Modified Davis grading; 45 degree fundus photograph; NIDEK AFC-230: 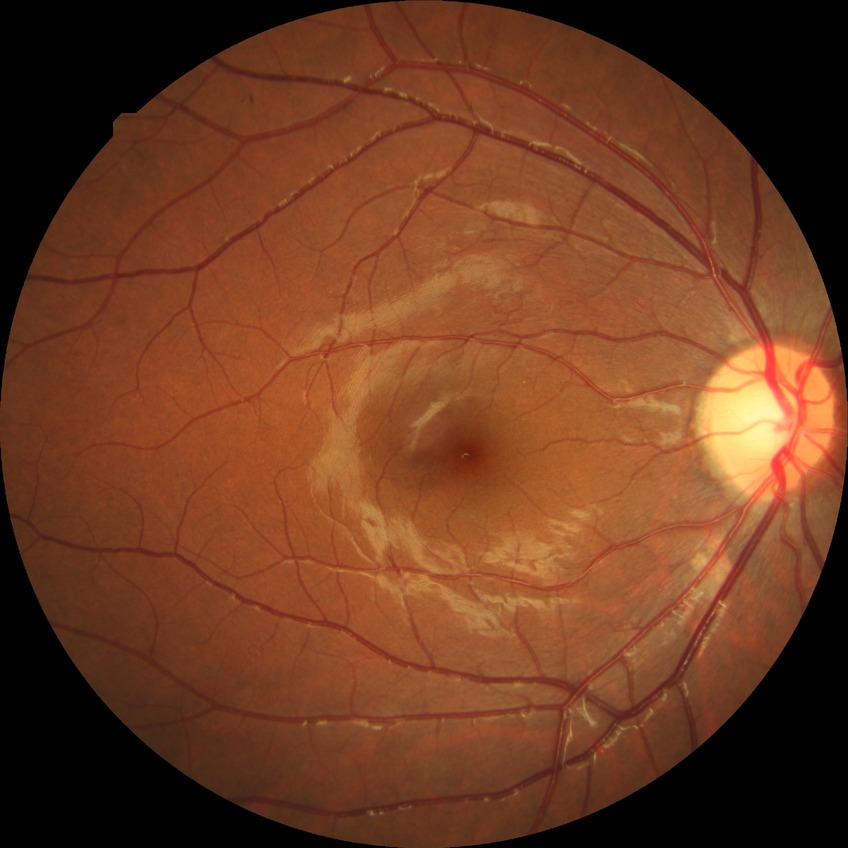

Annotations:
- retinopathy stage — simple diabetic retinopathy